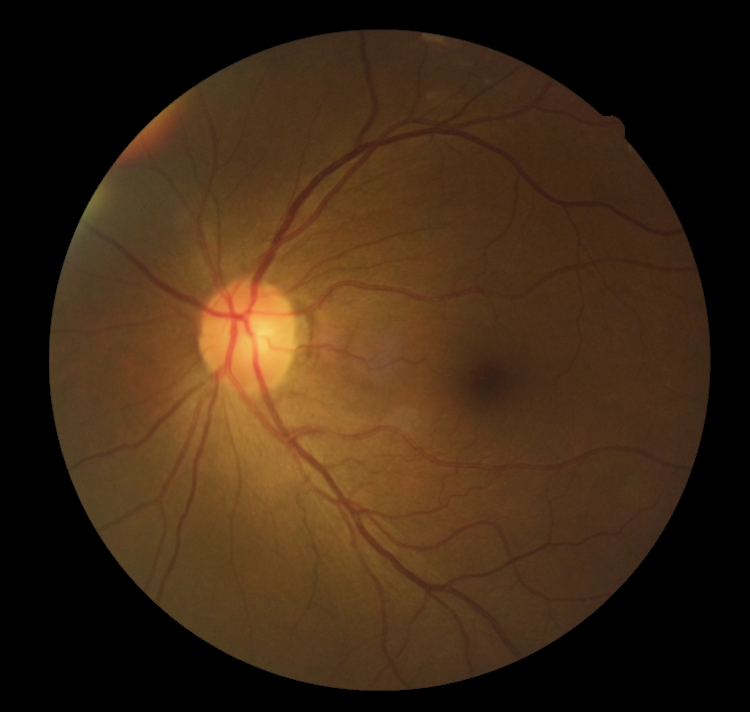
Diabetic retinopathy (DR) is grade 0 (no apparent retinopathy).